Acquired with a NIDEK AFC-230, nonmydriatic fundus photograph, posterior pole color fundus photograph:
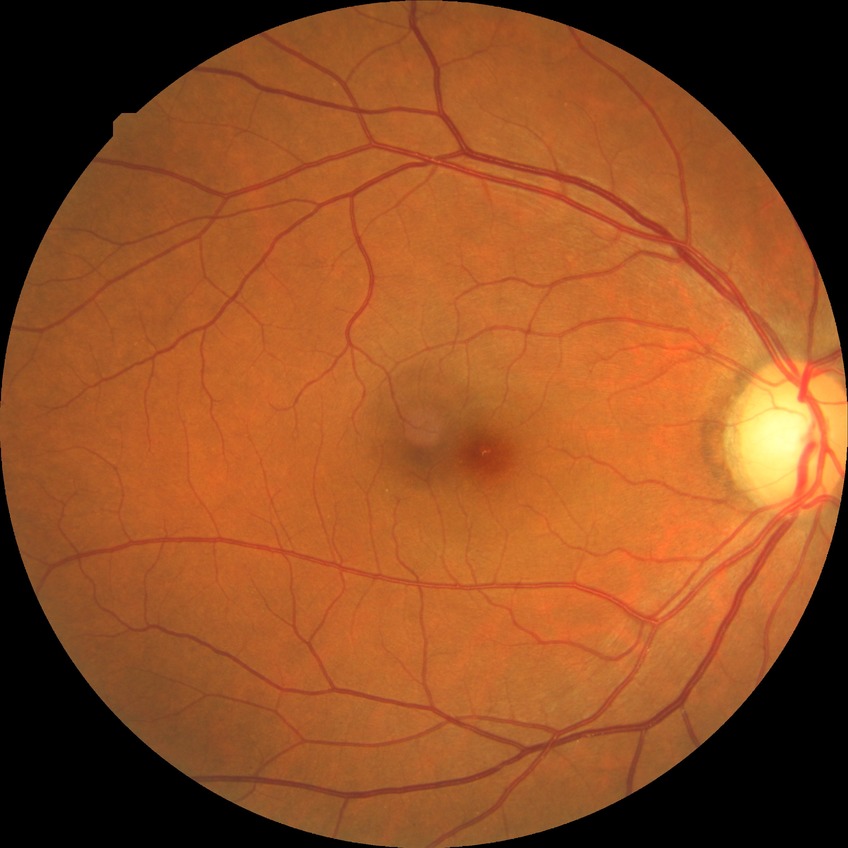

retinopathy grade: simple diabetic retinopathy